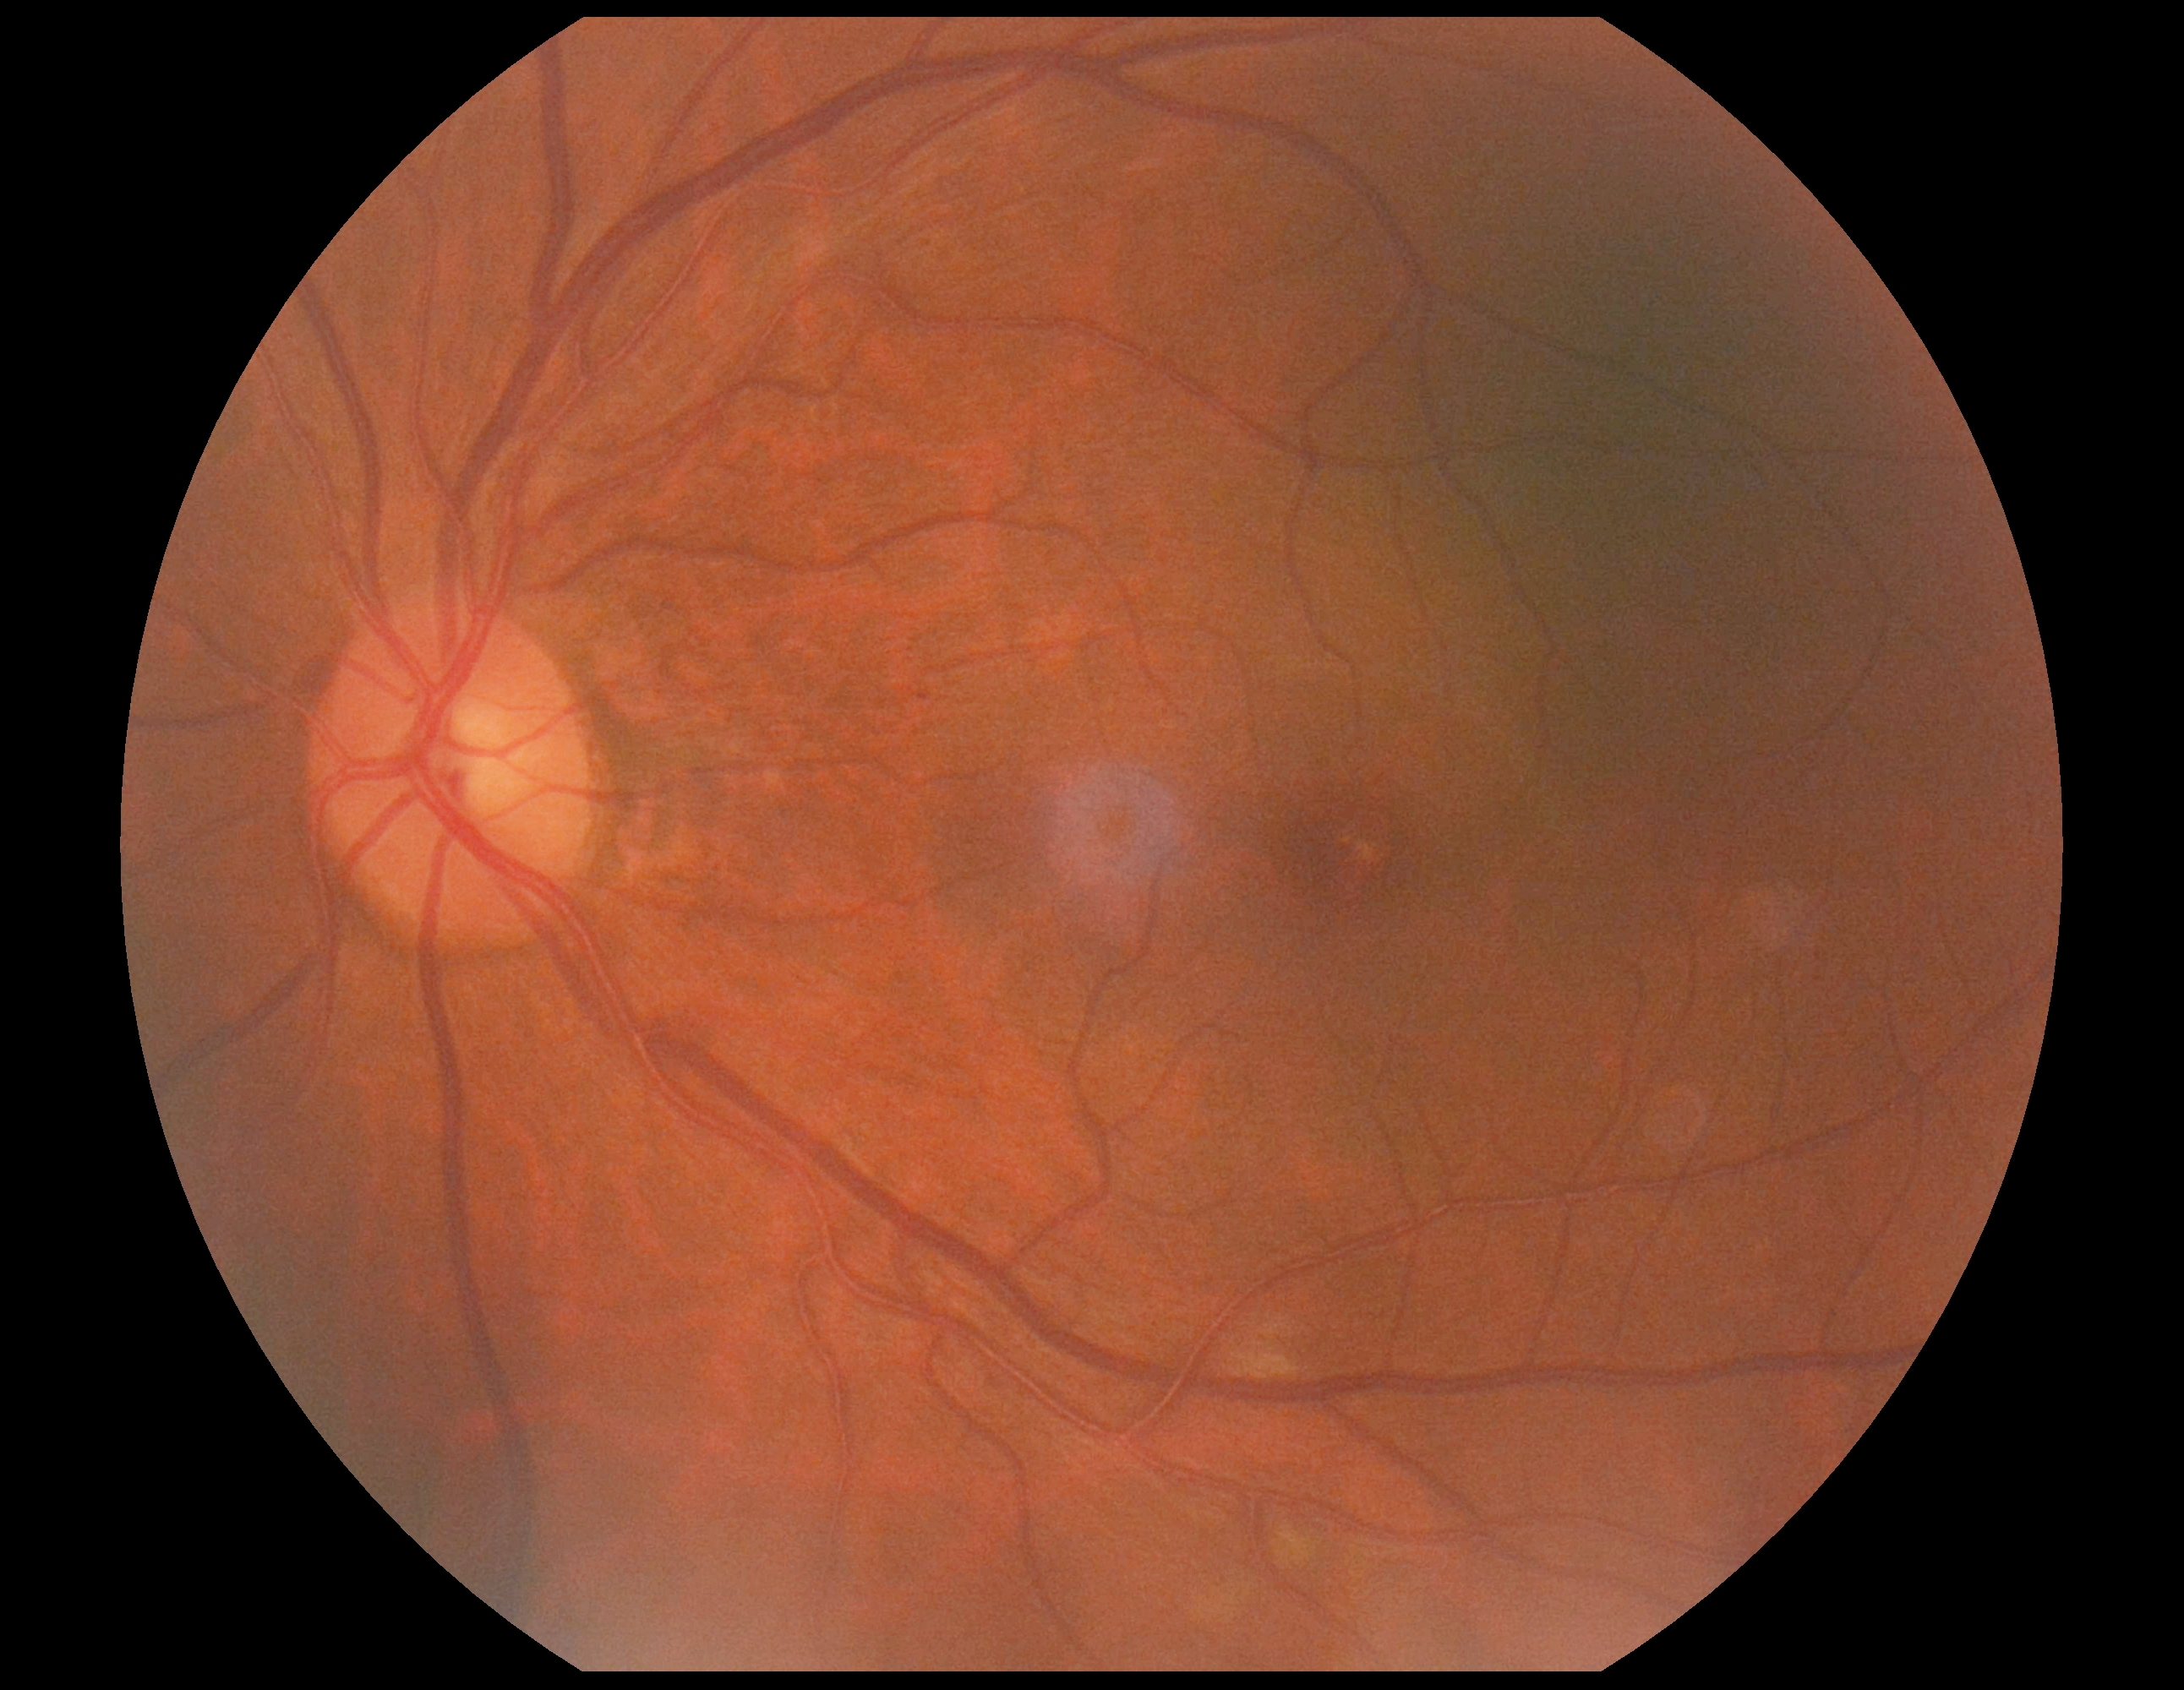 Diabetic retinopathy (DR): moderate NPDR (grade 2).